Modified Davis grading, without pupil dilation, FOV: 45 degrees, CFP, image size 848x848, NIDEK AFC-230 fundus camera:
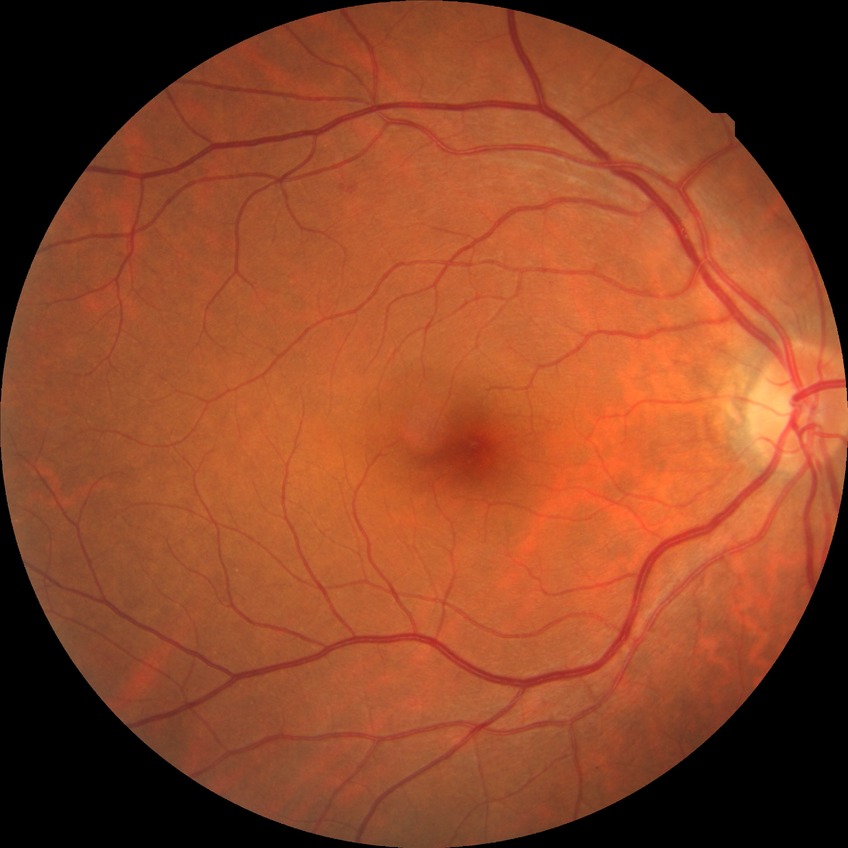
Retinopathy grade: no diabetic retinopathy.